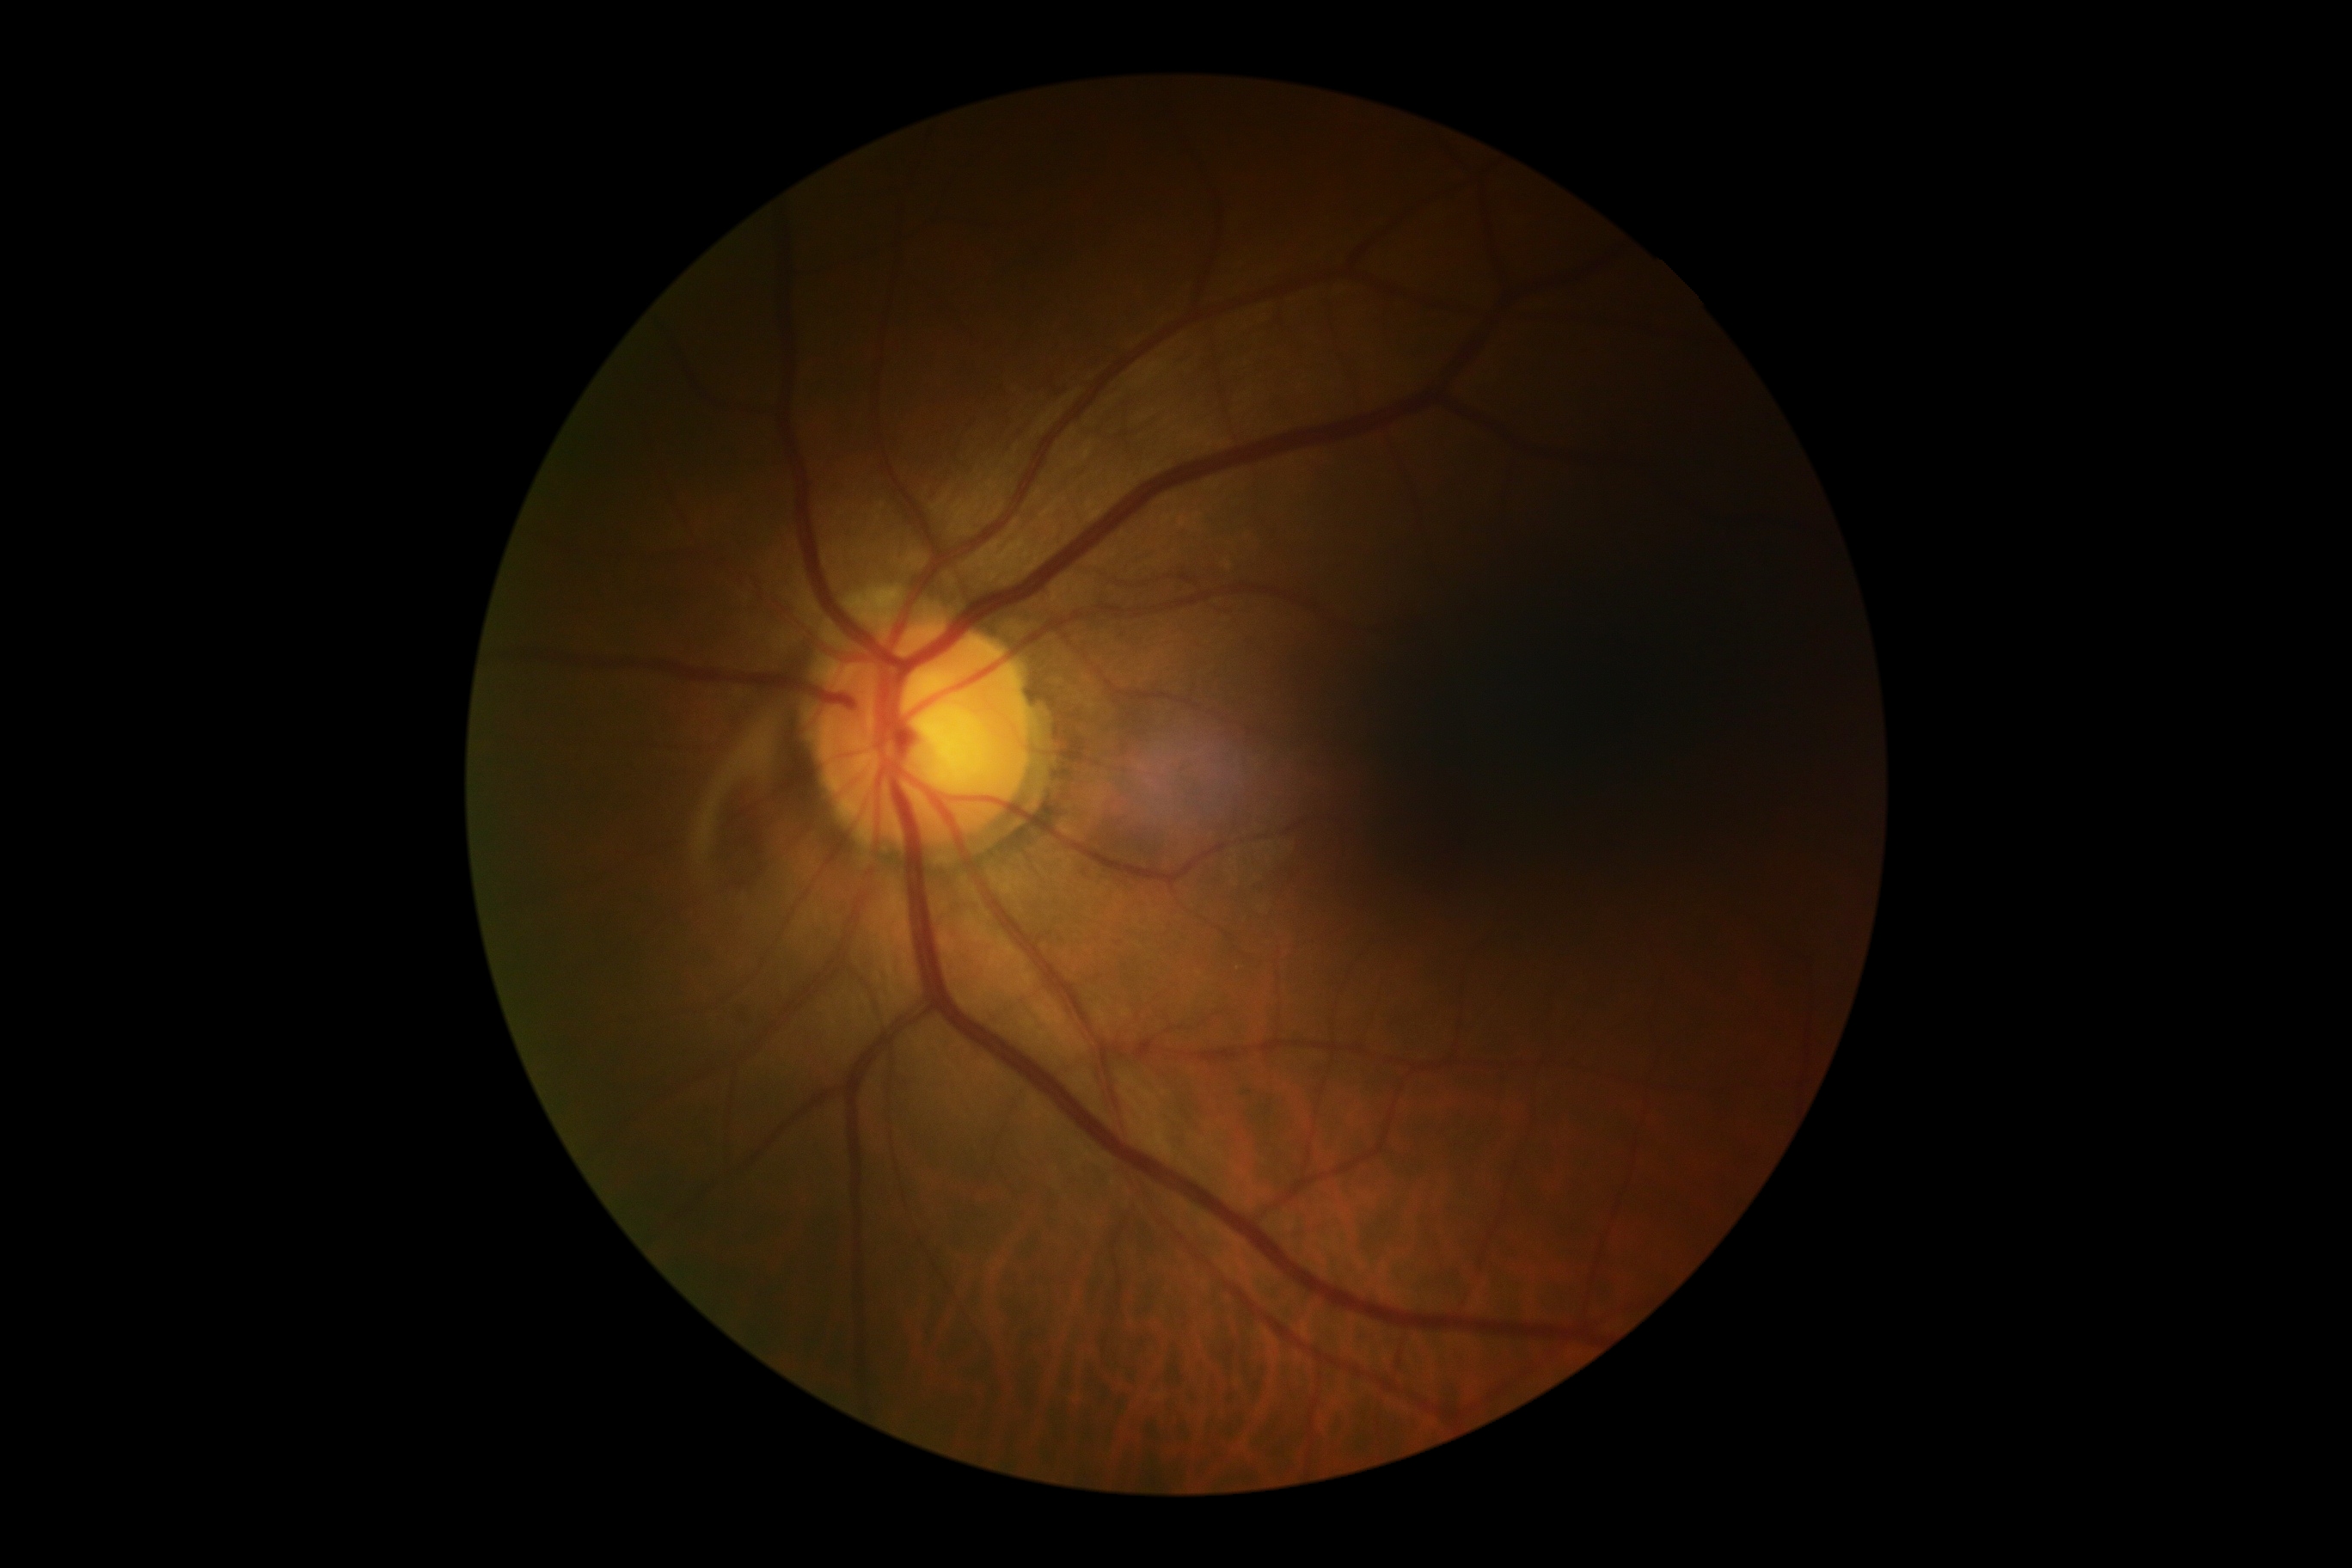 {
  "dr_grade": "grade 0 (no apparent retinopathy) — no visible signs of diabetic retinopathy"
}